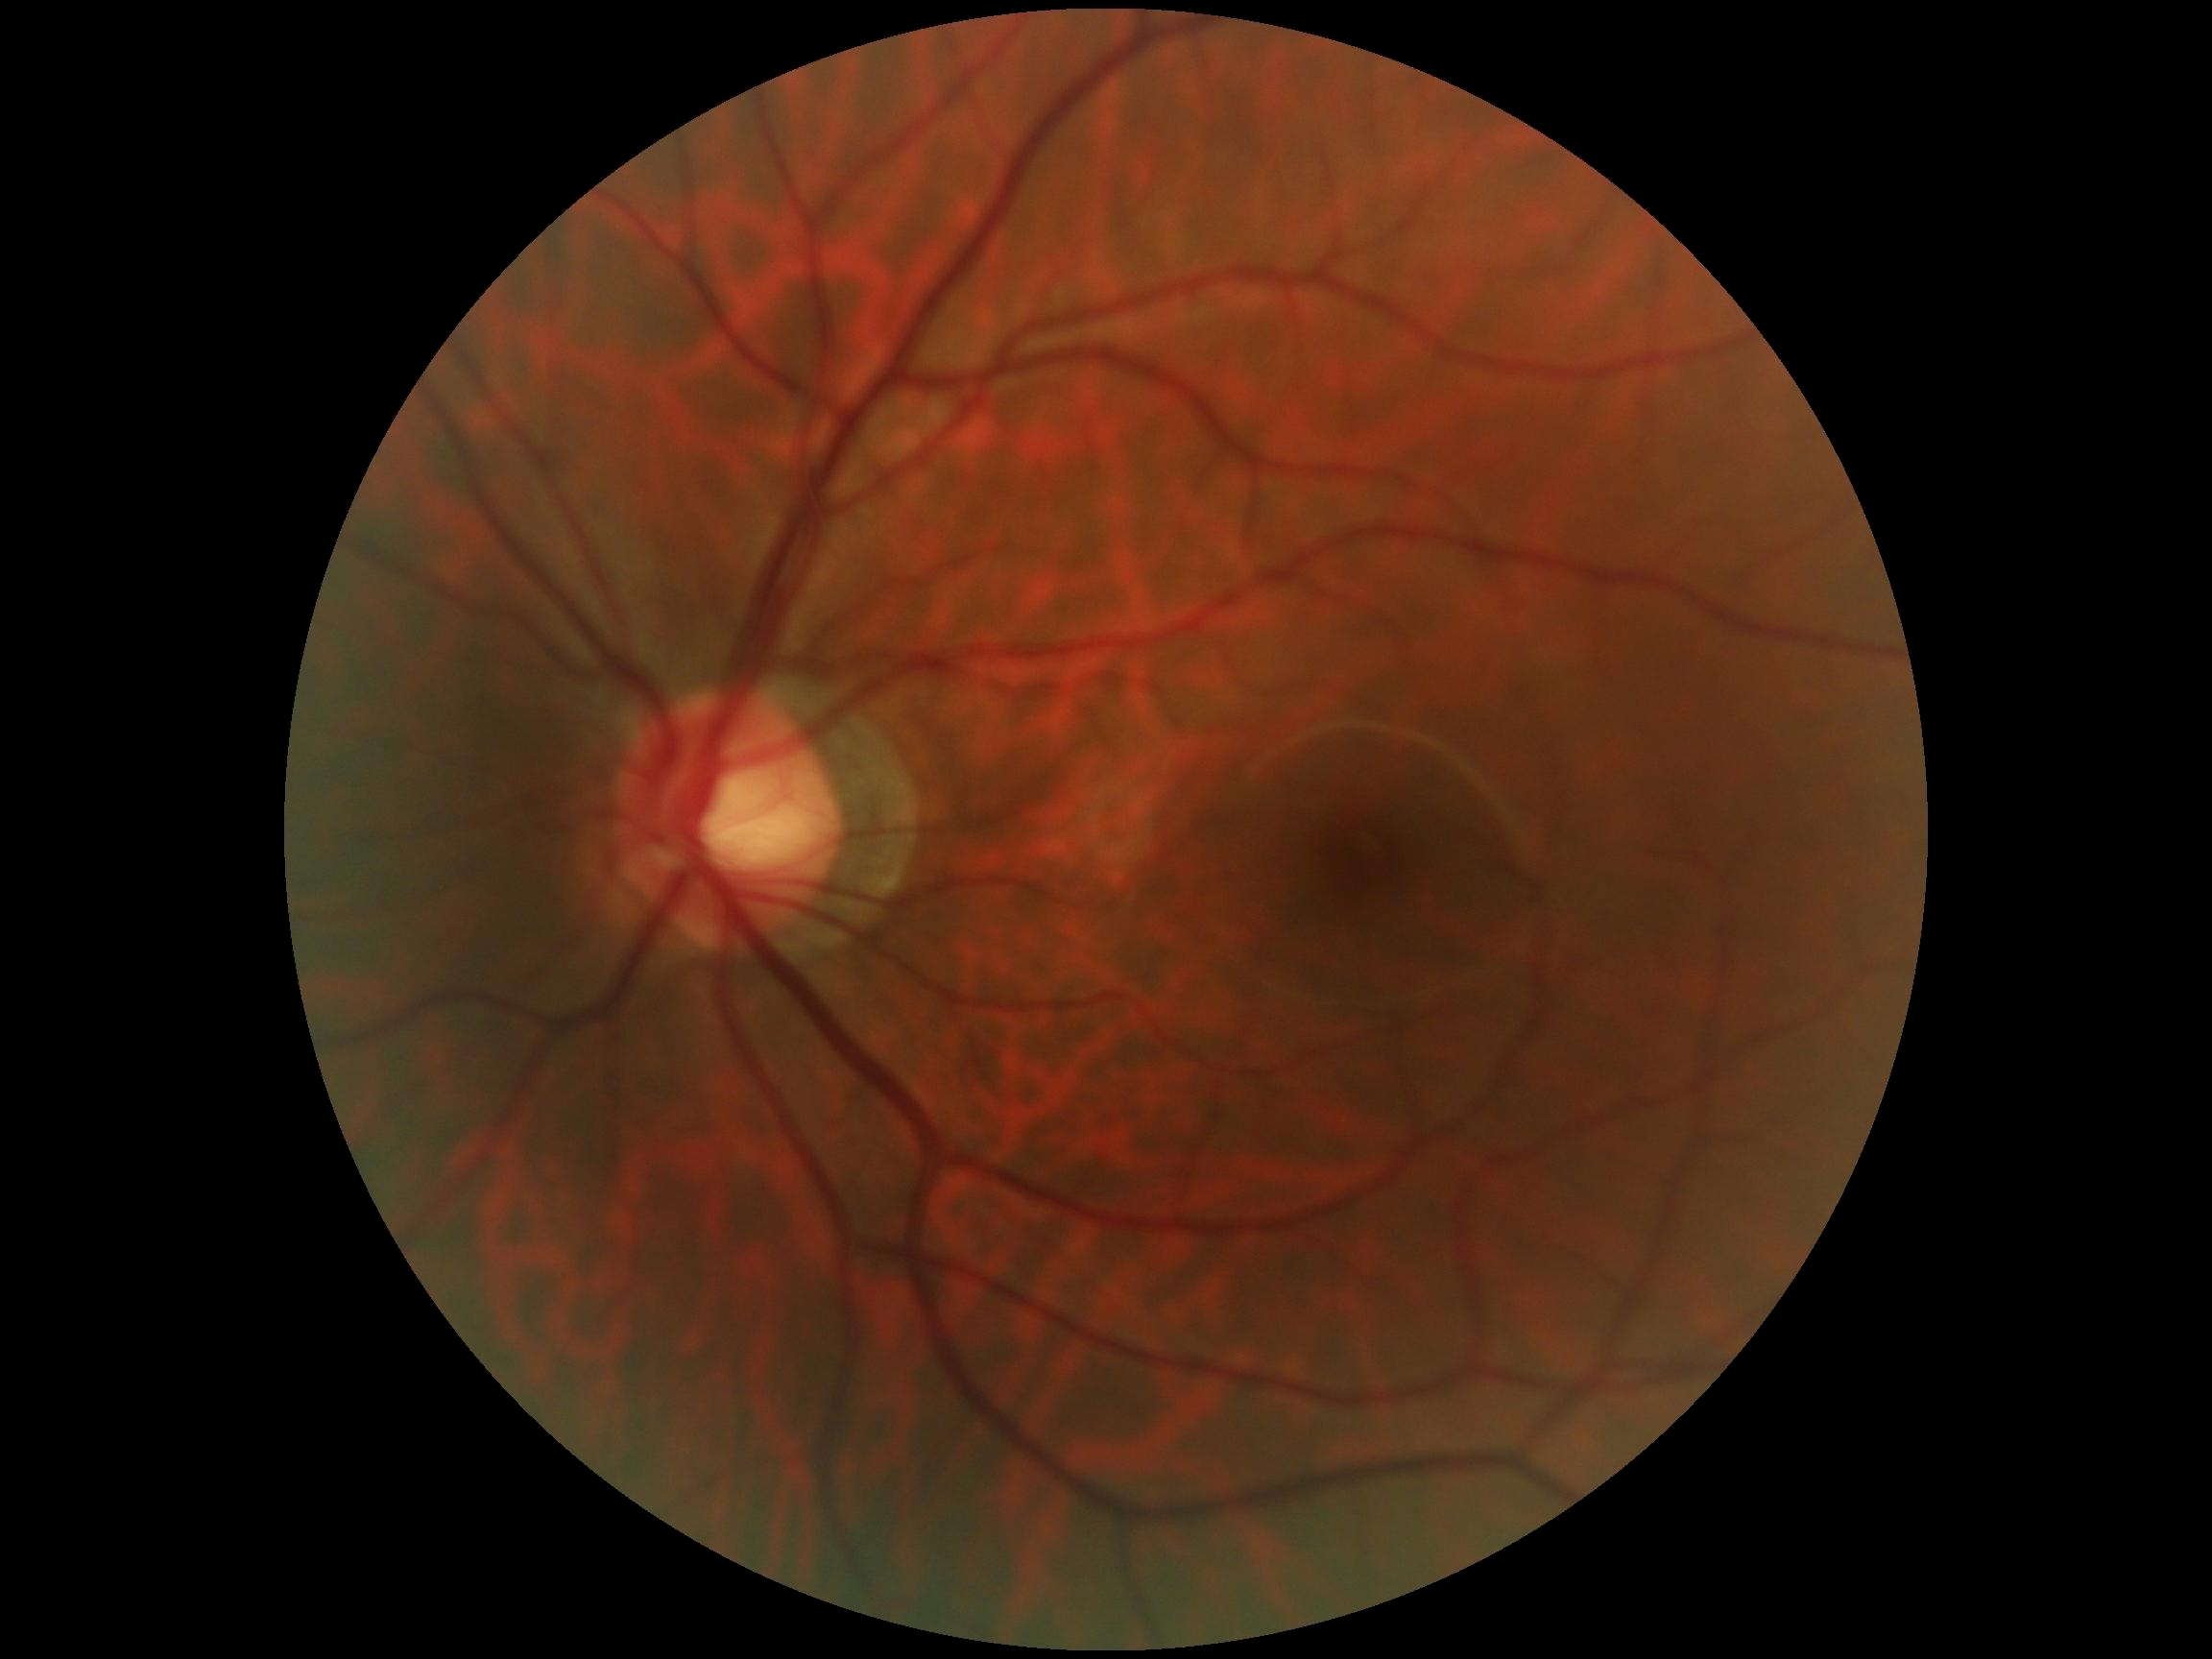 DR stage: grade 0 (no apparent retinopathy). No diabetic retinal disease findings.